45° FOV · 2212x1659px · fundus photo.
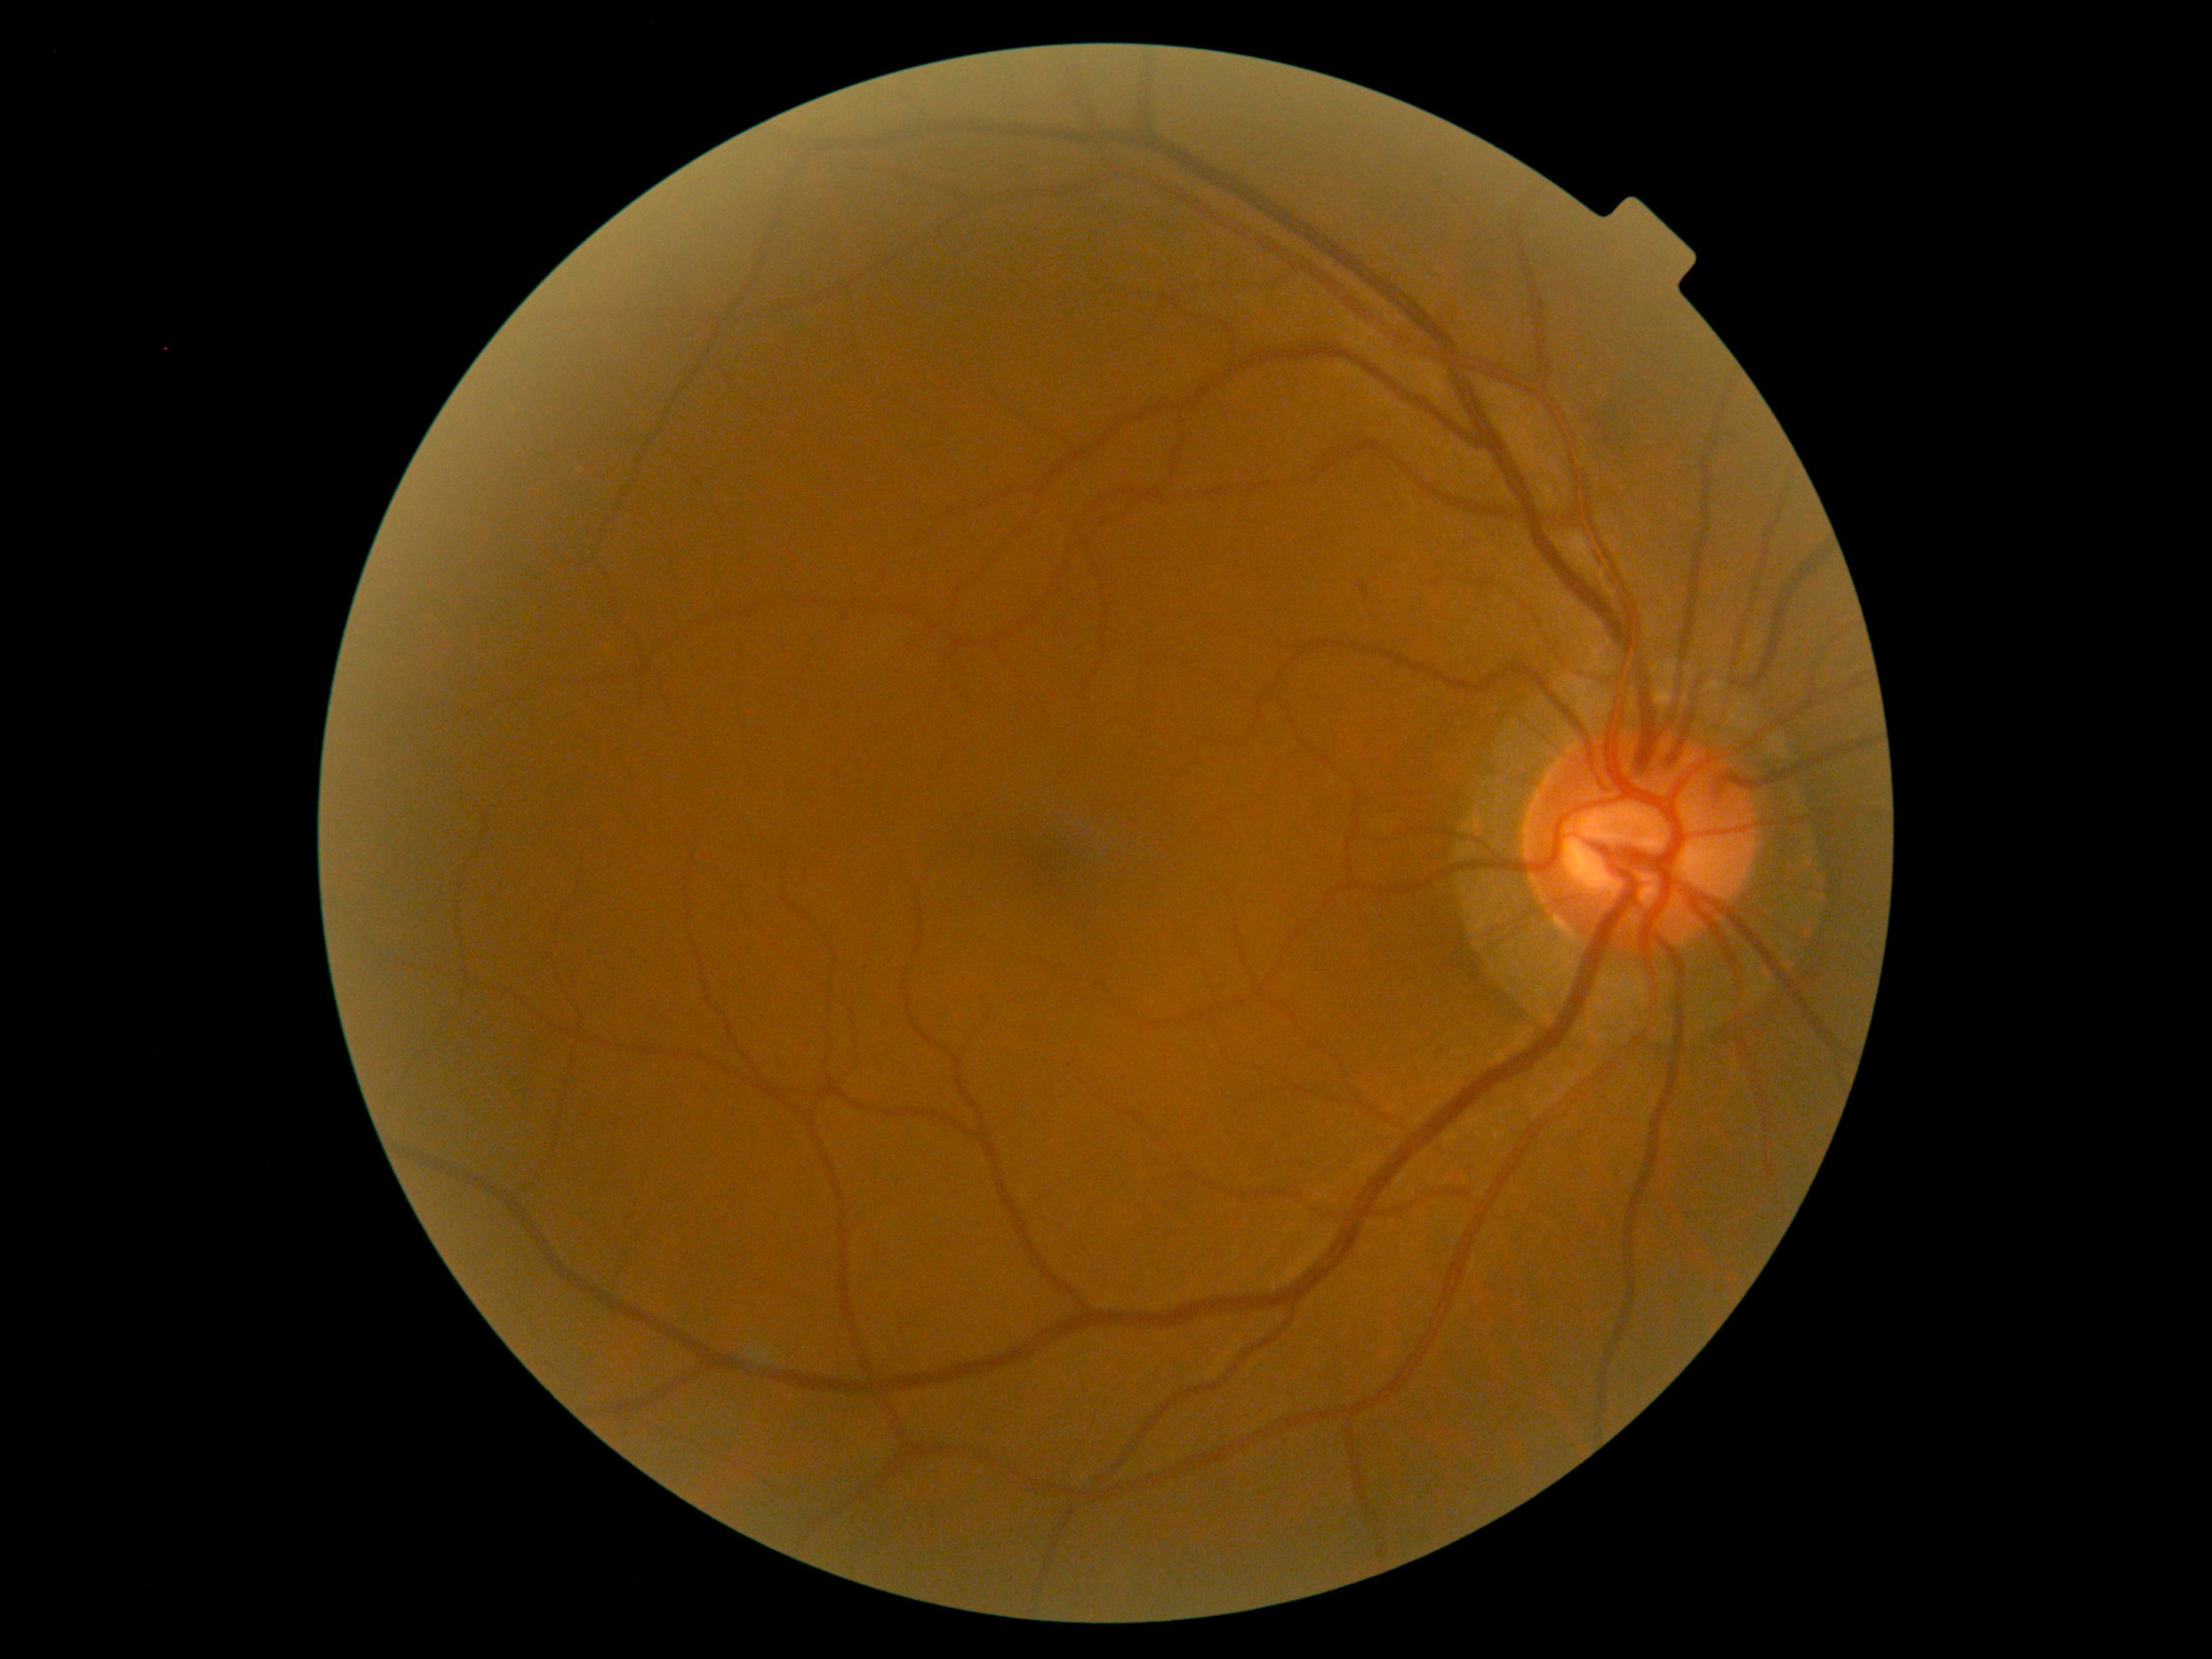

No DR findings. DR is 0 — no visible signs of diabetic retinopathy.